Fundus photo — 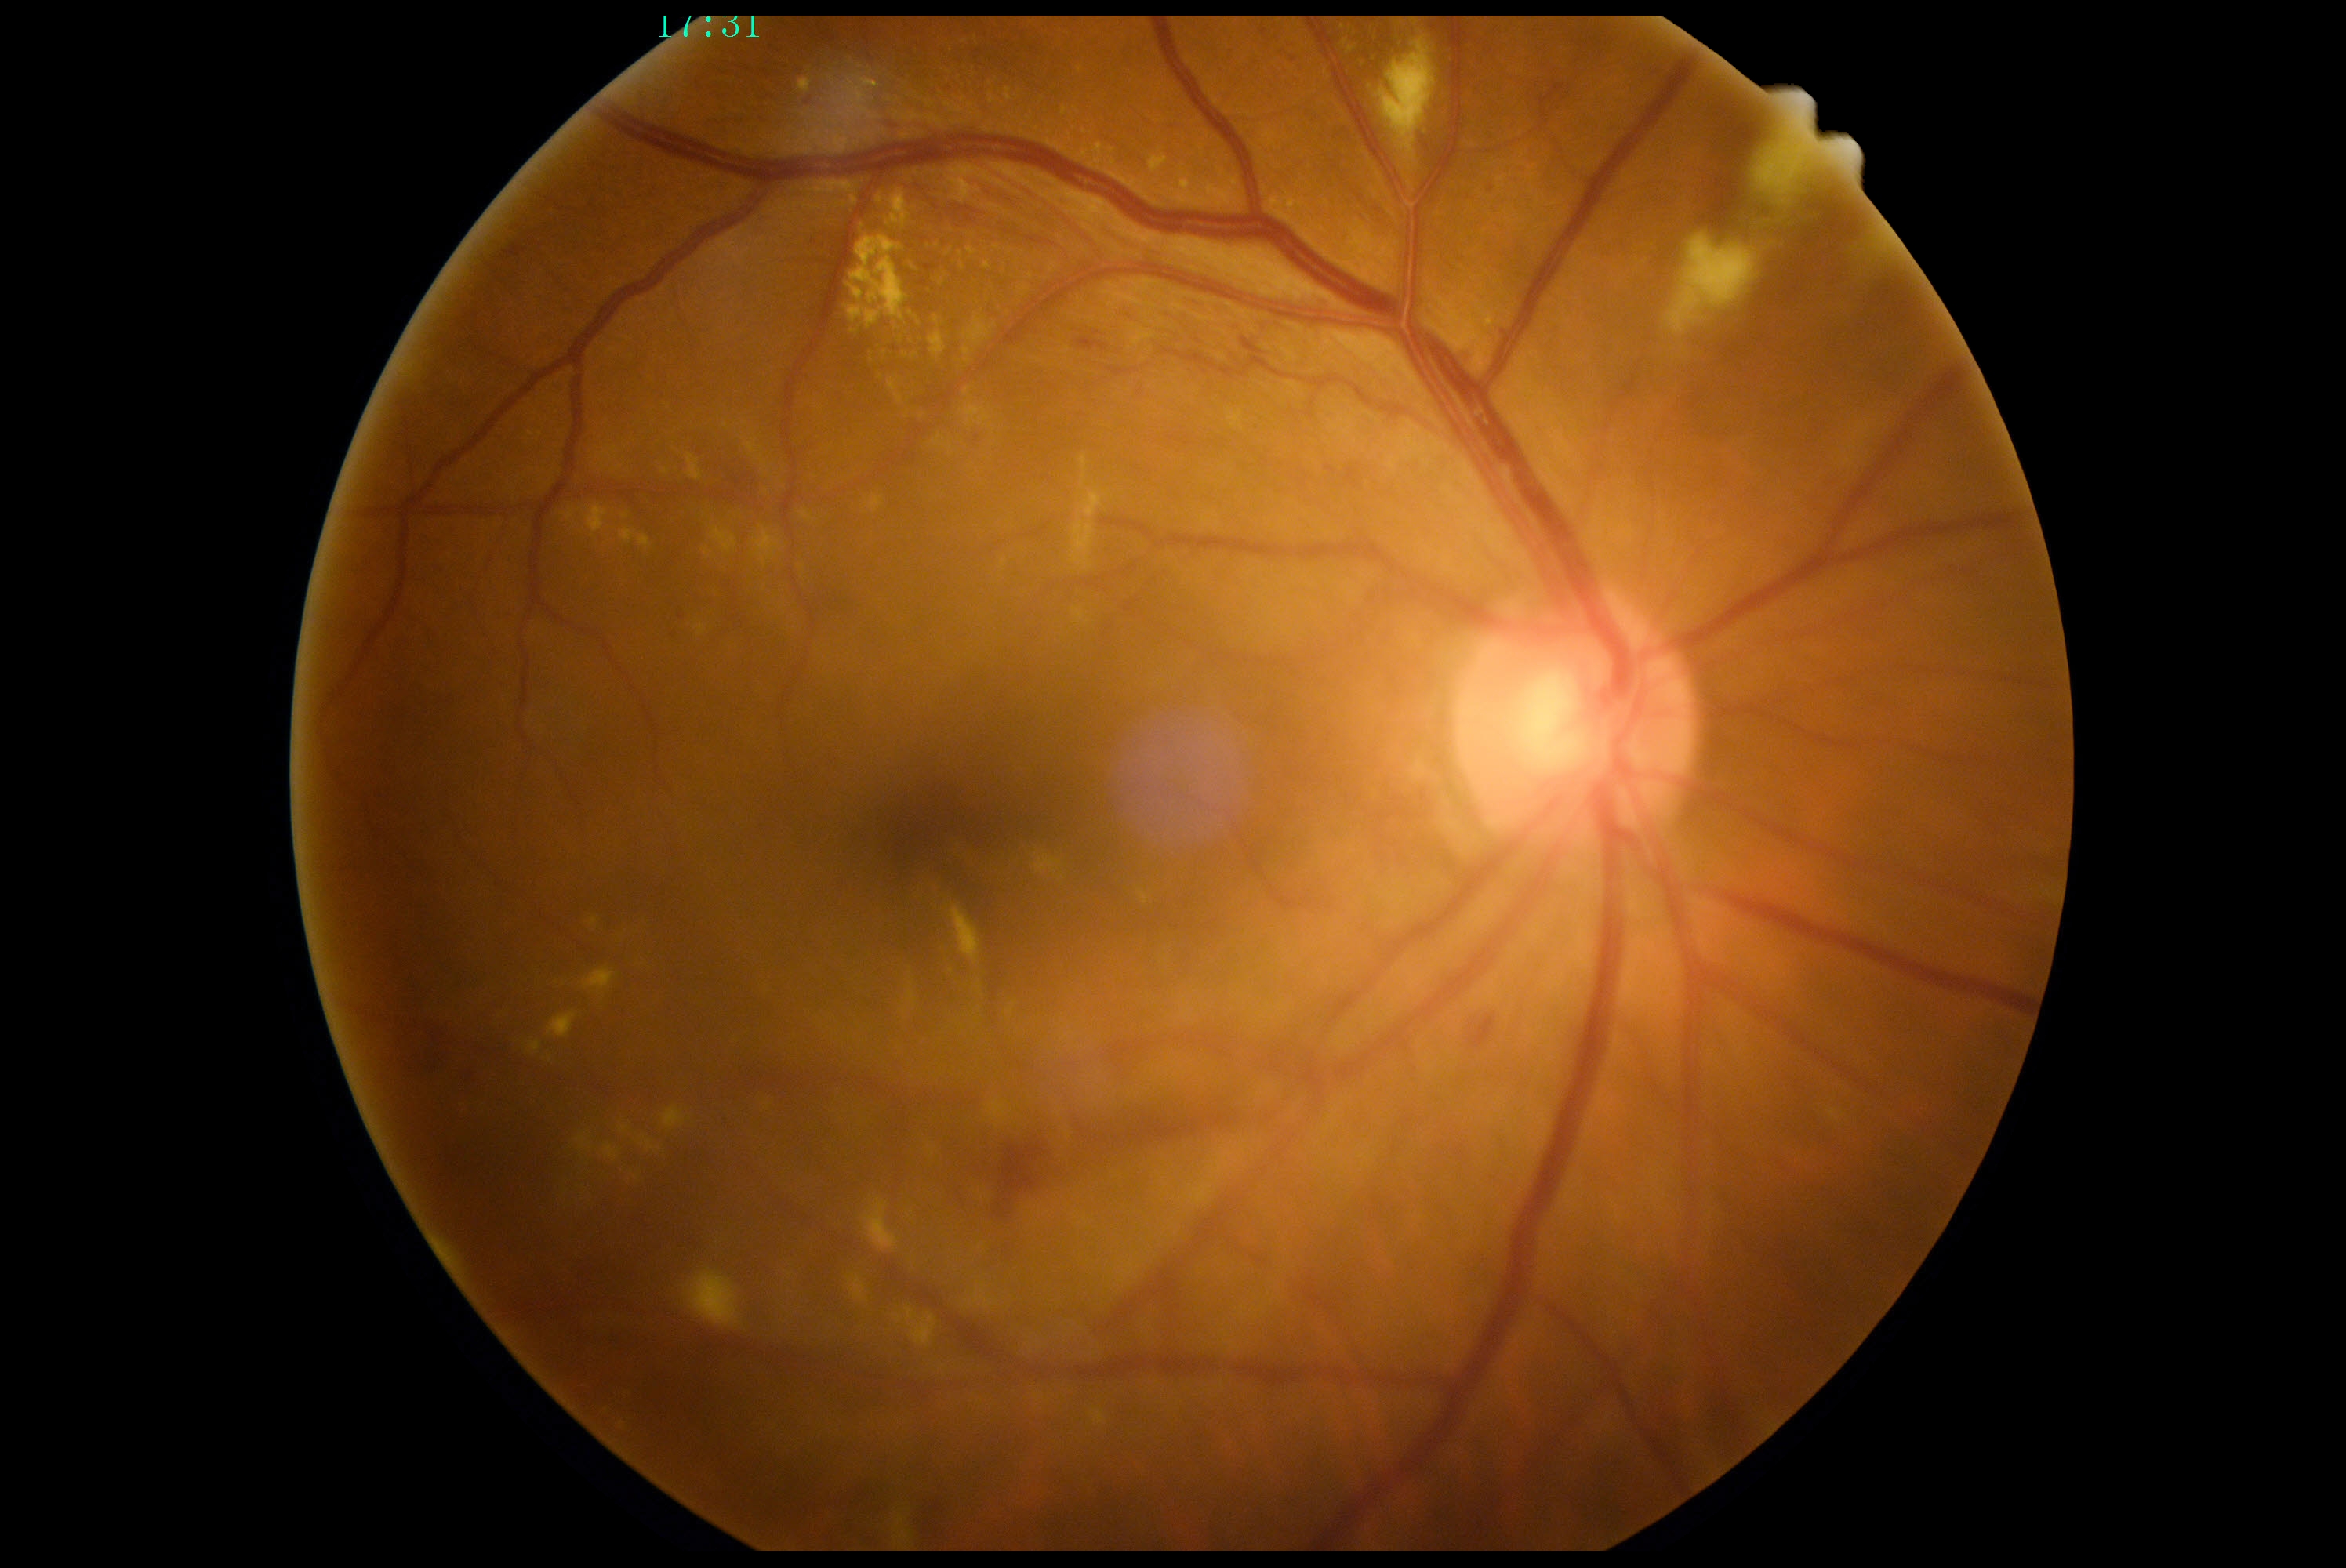 {"dr_grade": "2/4", "dr_category": "non-proliferative diabetic retinopathy"}